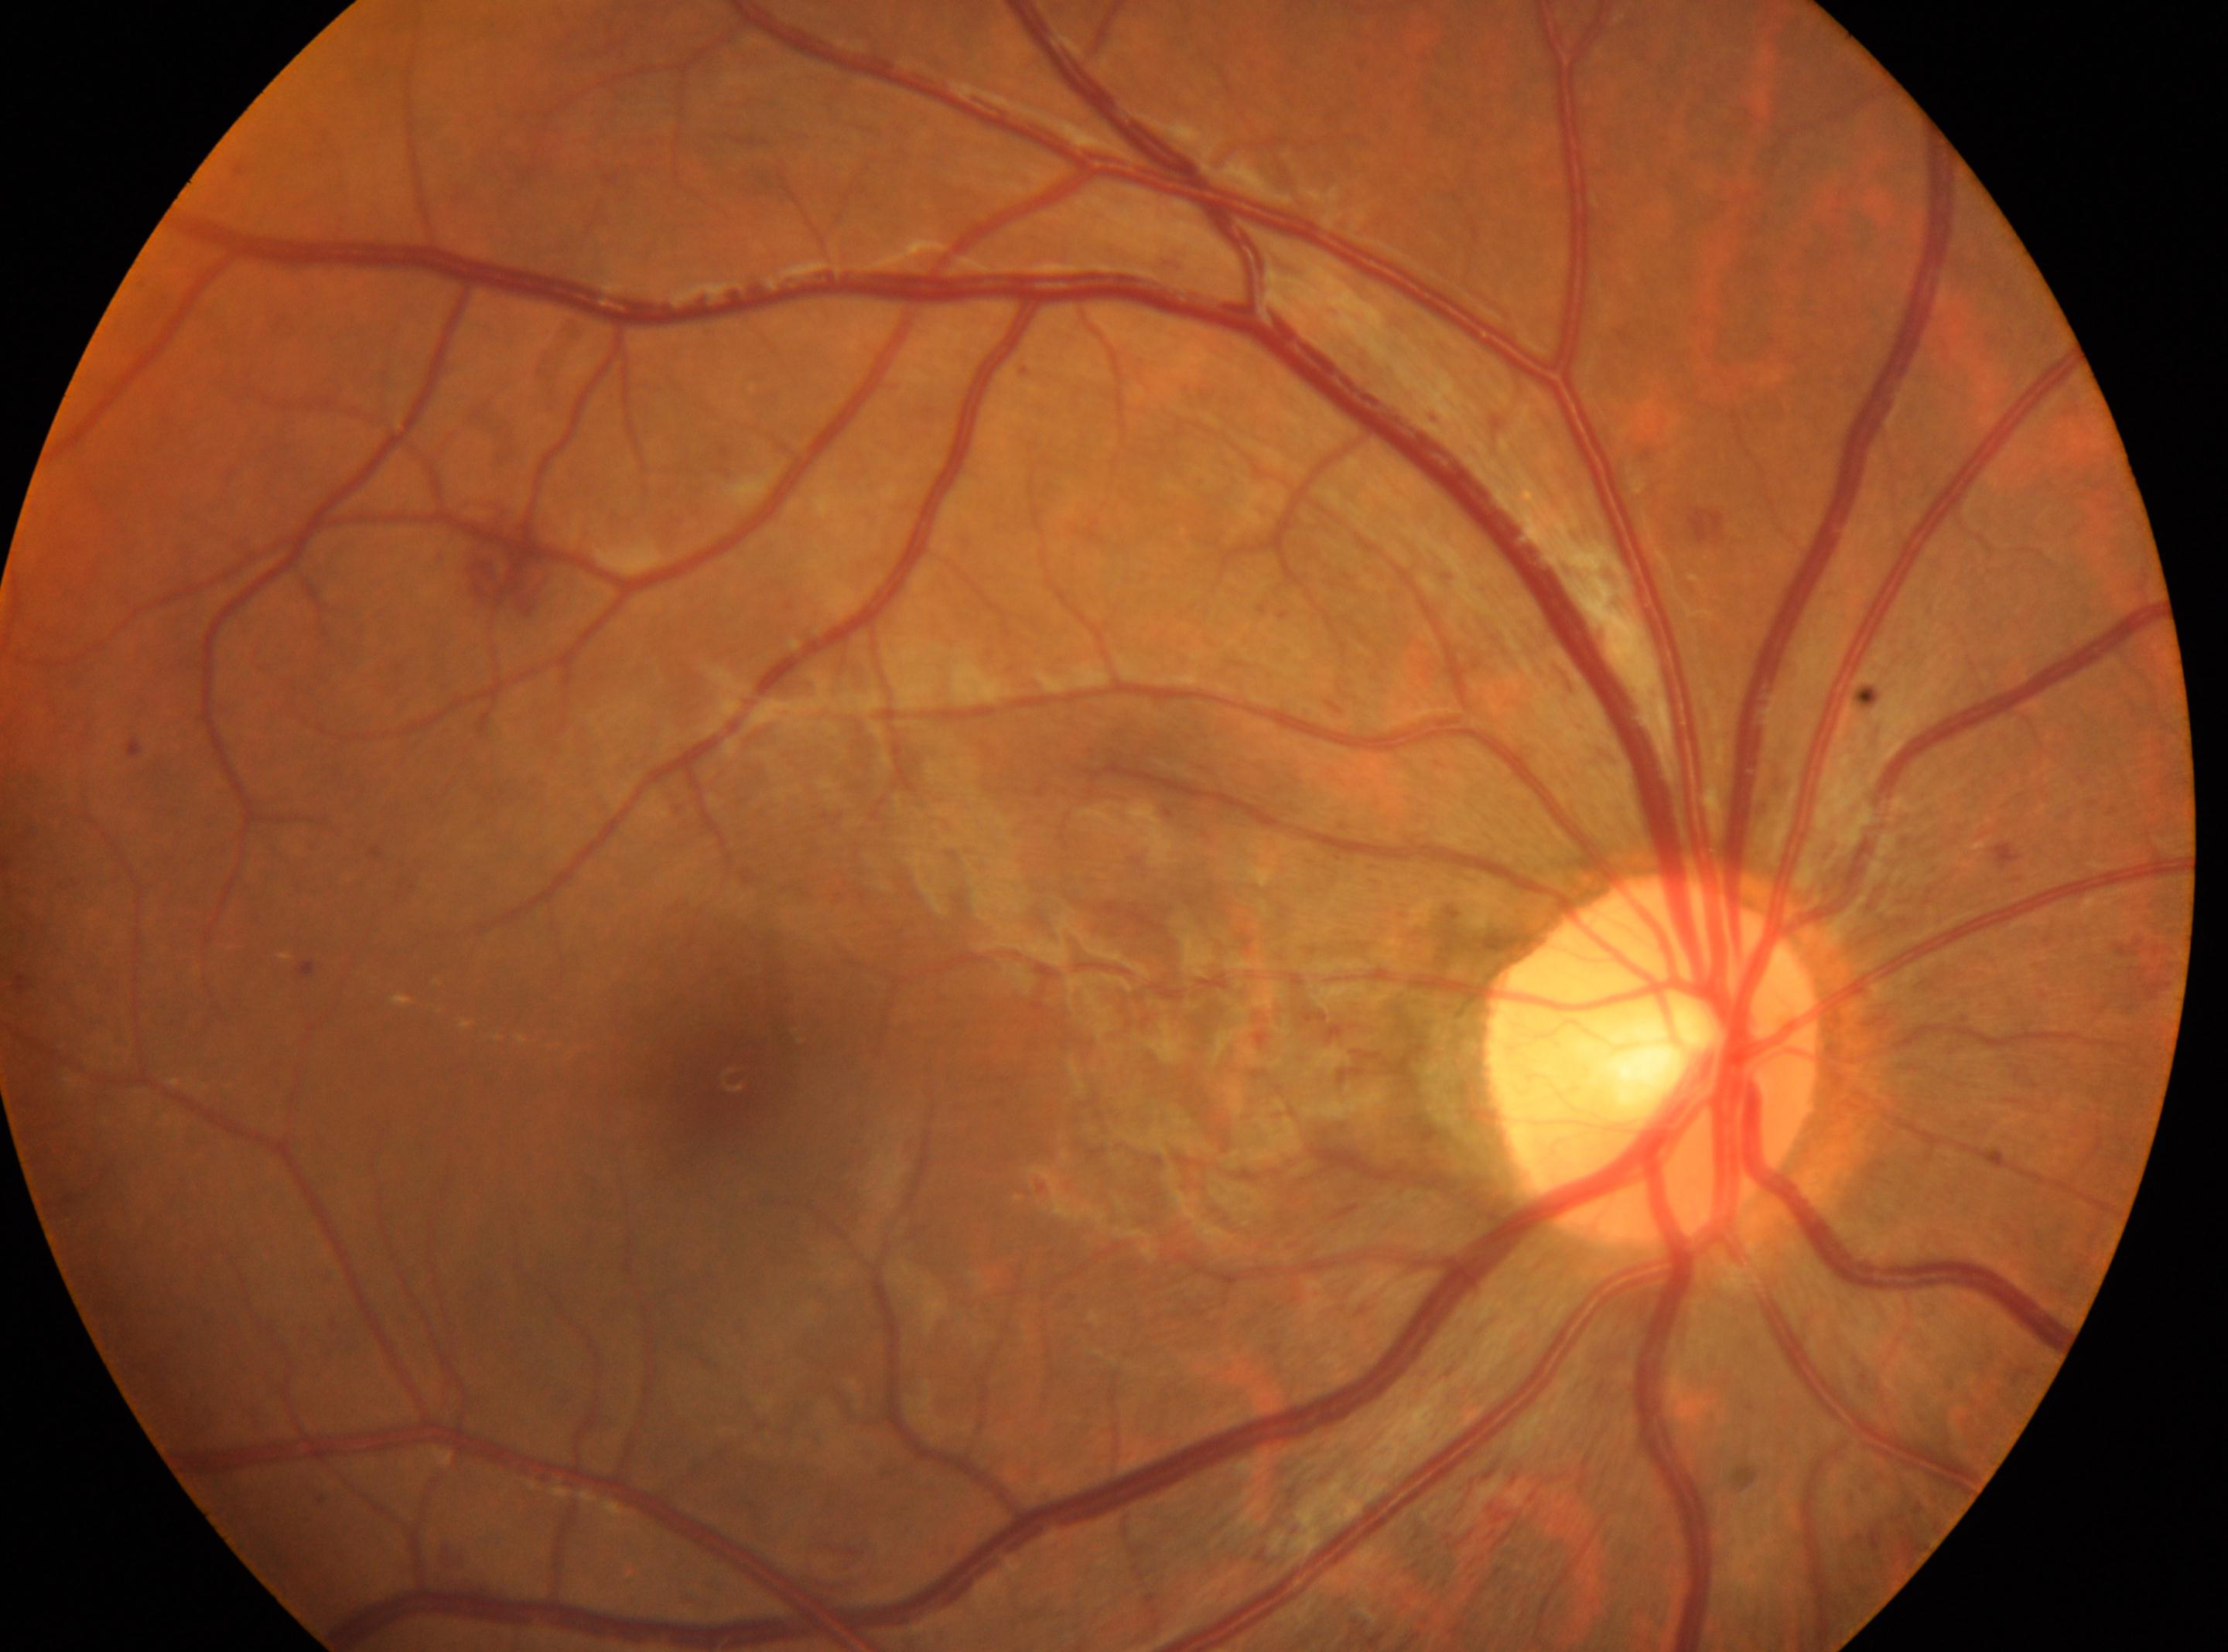
Optic disc: (x=1652, y=1059). DR severity is grade 2 (moderate NPDR). DR class: non-proliferative diabetic retinopathy. Fovea centralis: (x=721, y=1073). Eye: right eye.